Refraction: -1 -2.75 x 100 · 30-degree field of view · IOP: 18 mmHg · man · disc-centered field · axial length: 24.62 mm.
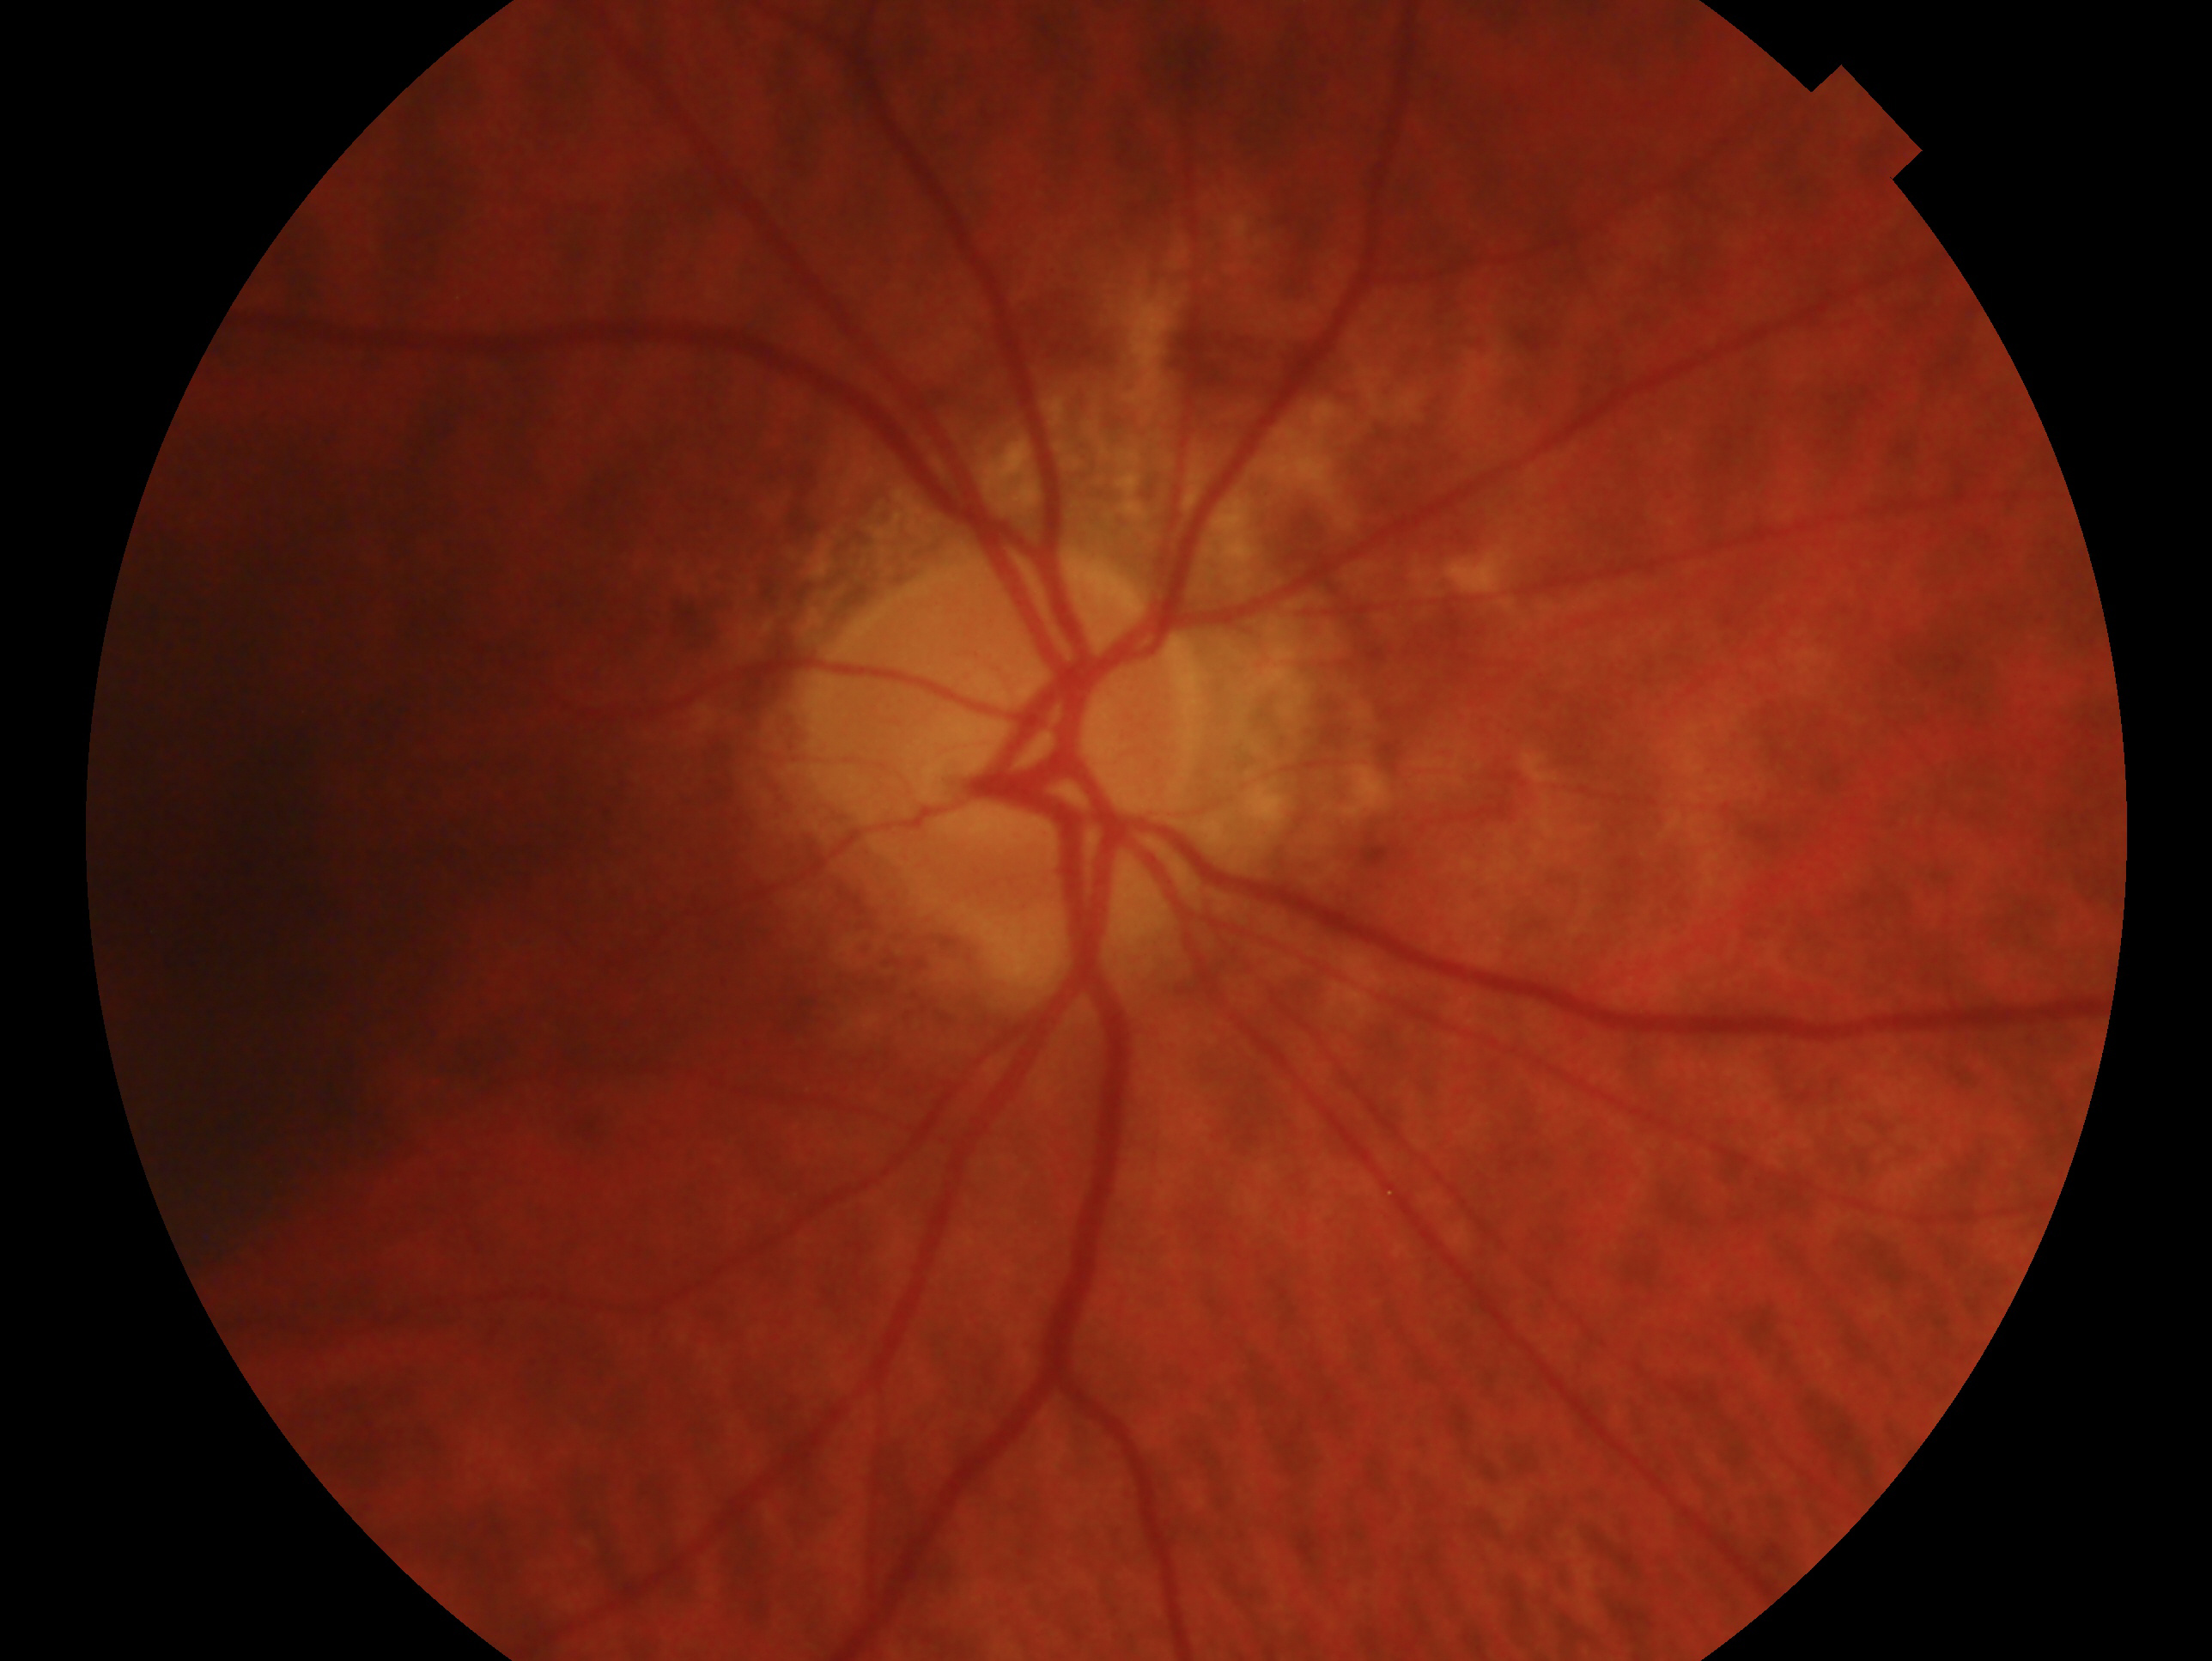
Q: Glaucoma classification?
A: glaucomatous optic neuropathy
Q: Which eye is imaged?
A: right eye